Image size 2048x1536 — 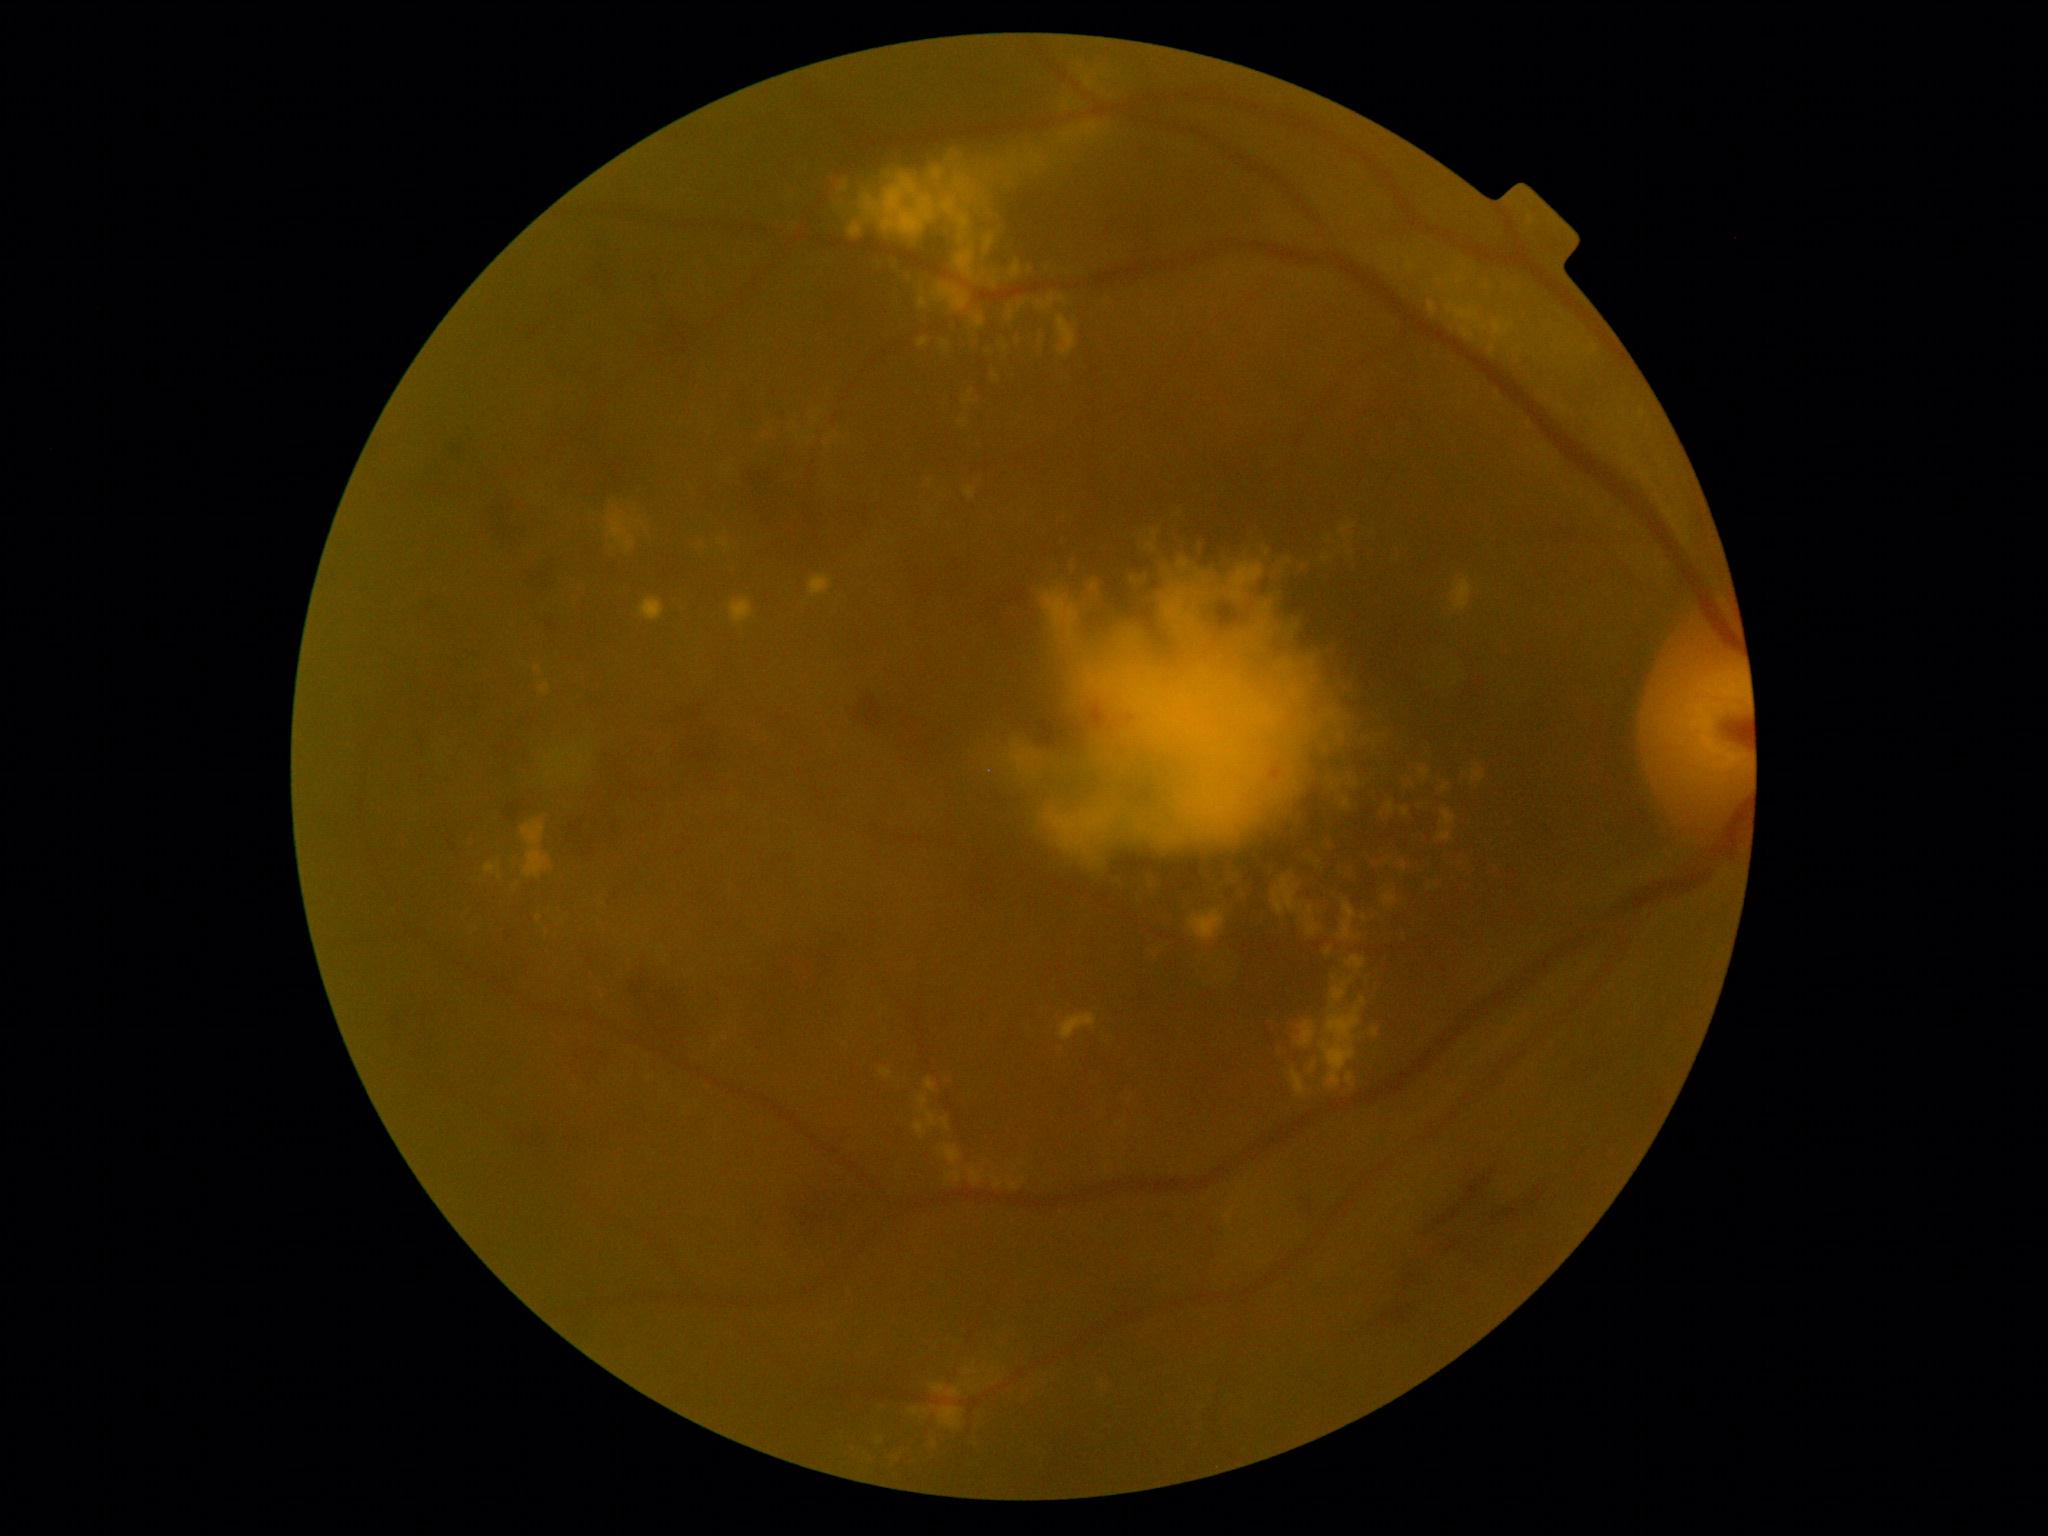

<lesions partial="true">
  <dr_grade>2</dr_grade>
  <ex partial="true">BBox(964, 487, 977, 499), BBox(891, 1429, 947, 1462), BBox(1429, 301, 1437, 317), BBox(915, 1121, 928, 1138), BBox(1325, 519, 1358, 558), BBox(1457, 277, 1463, 285), BBox(1060, 1014, 1097, 1041), BBox(843, 1445, 879, 1467), BBox(1077, 122, 1100, 139), BBox(1444, 856, 1473, 877), BBox(1046, 262, 1056, 281), BBox(1400, 860, 1407, 870), BBox(809, 575, 833, 596), BBox(1341, 862, 1361, 879), BBox(1038, 294, 1056, 311), BBox(919, 338, 929, 348)</ex>
  <ex_small_centers>[1493, 349], [1449, 281]</ex_small_centers>
</lesions>